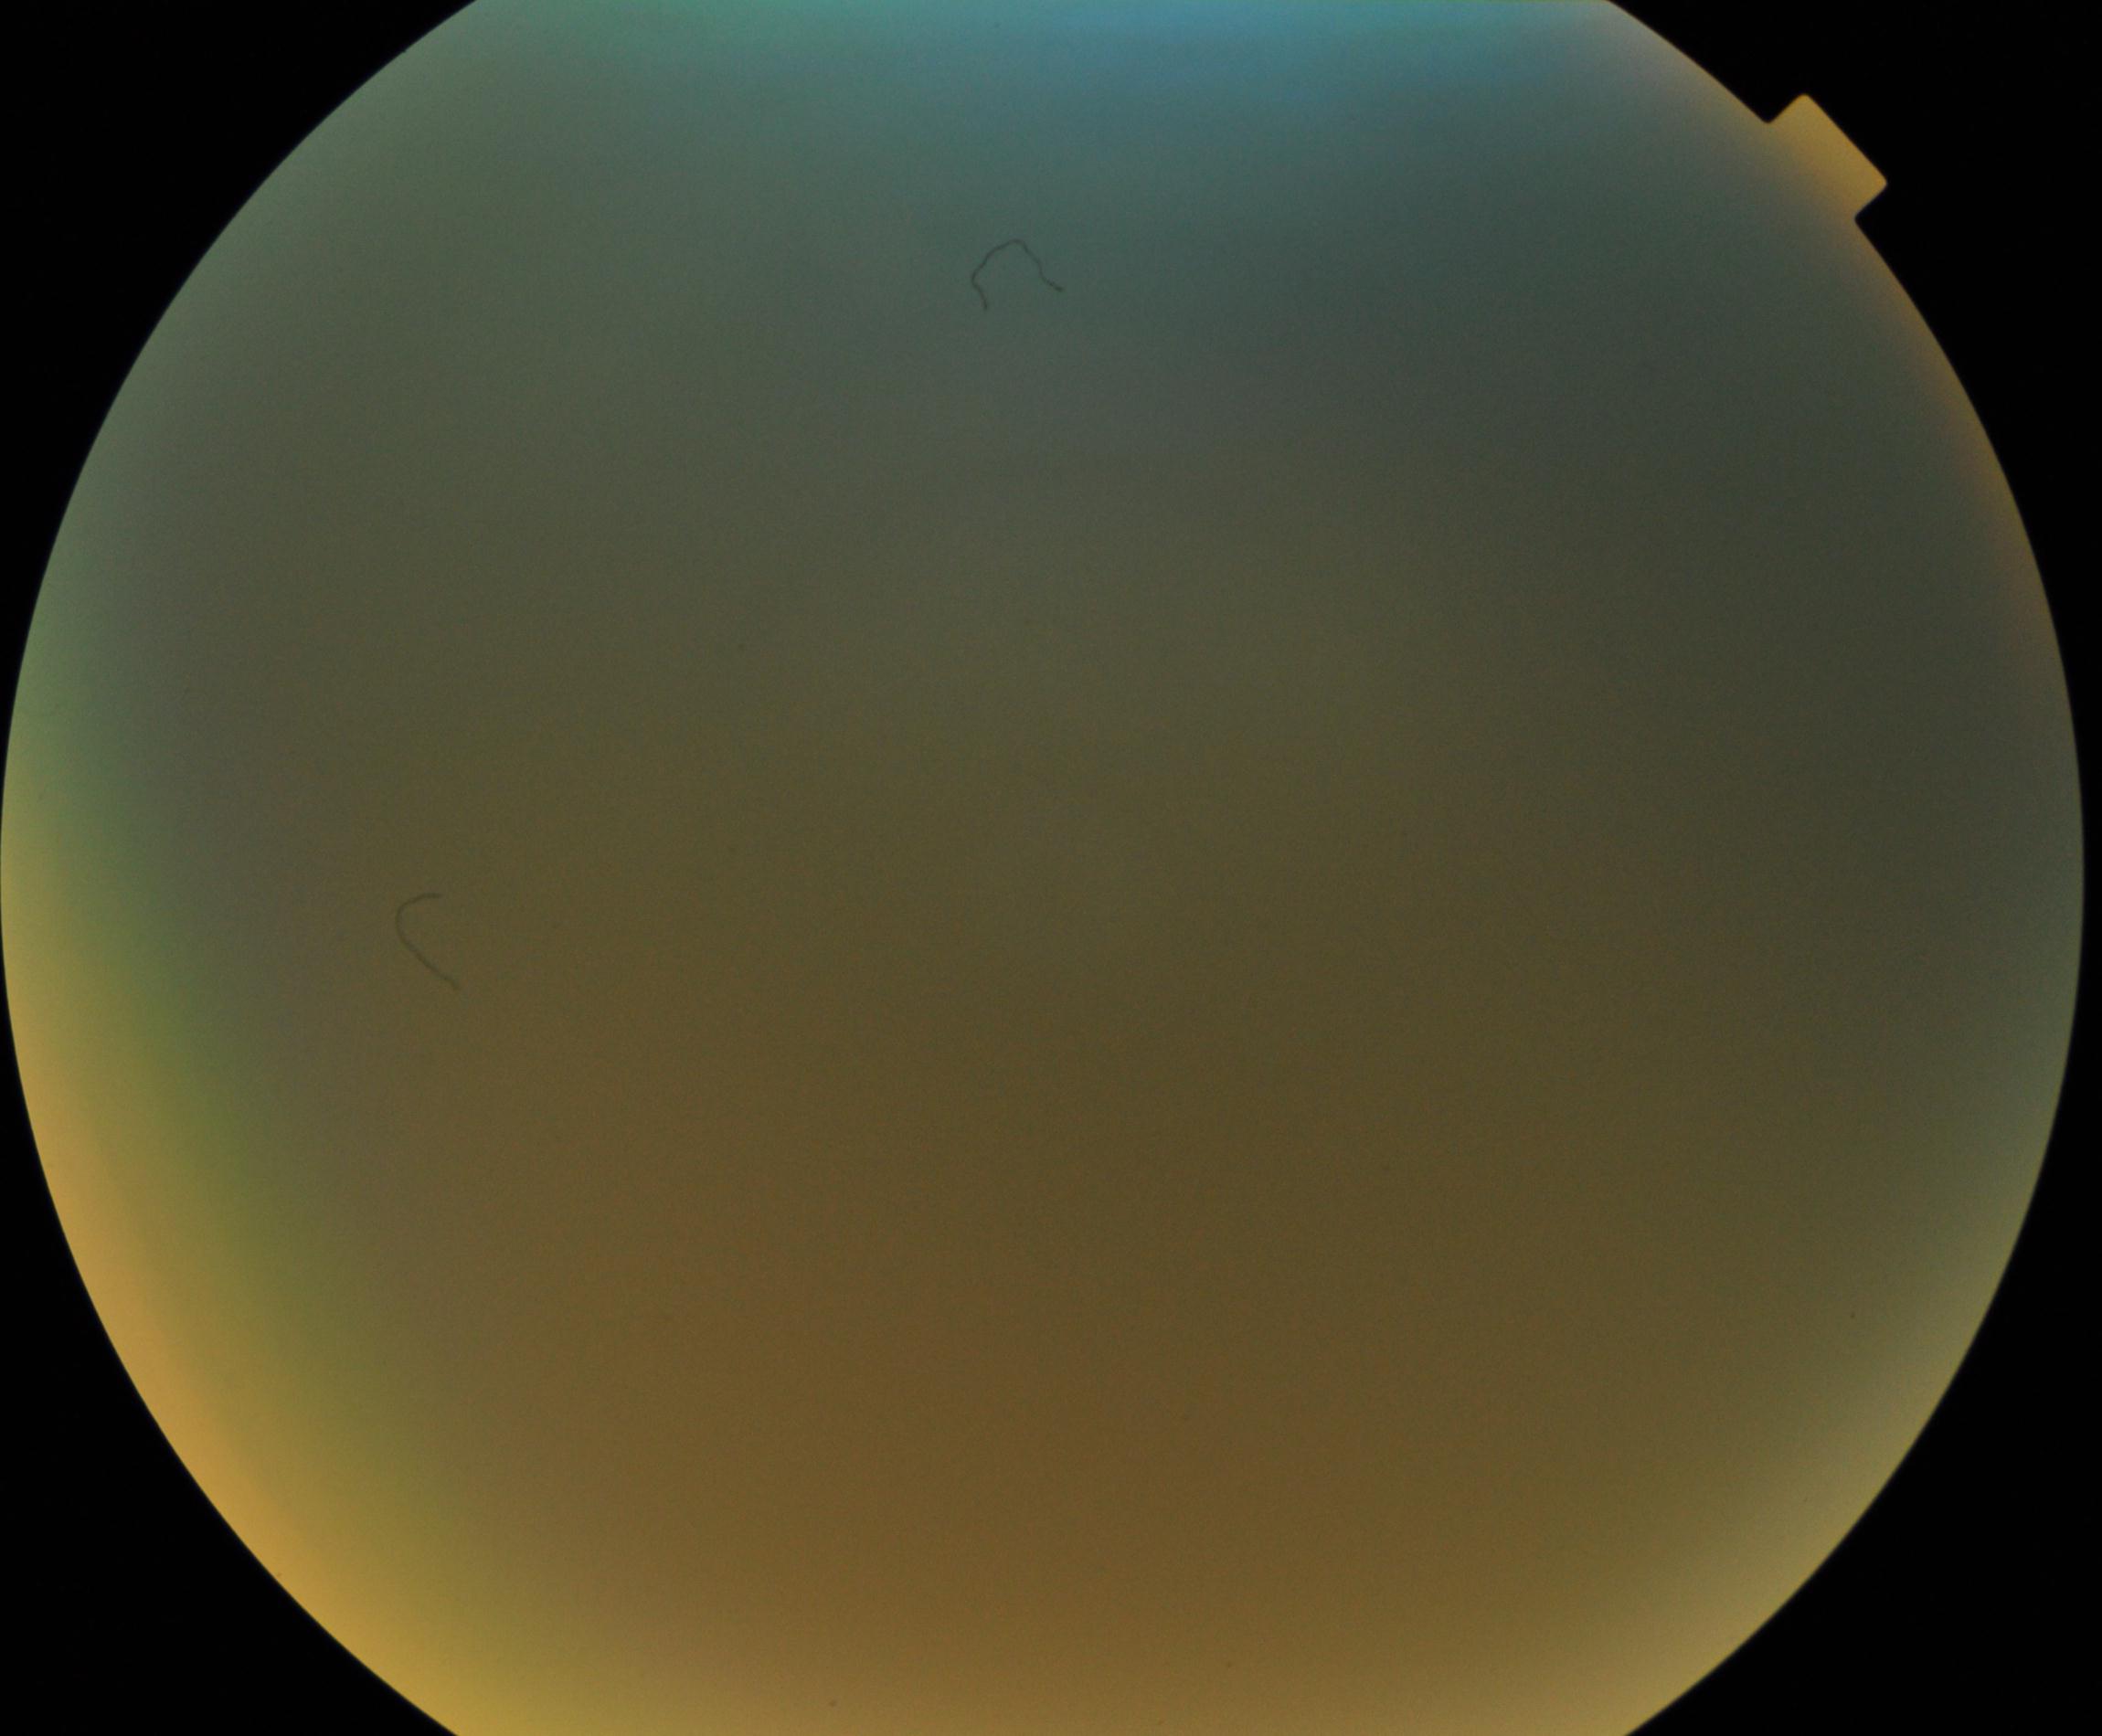

Image quality: poor. Proliferative retinopathy: not identified.